45° FOV · retinal fundus photograph: 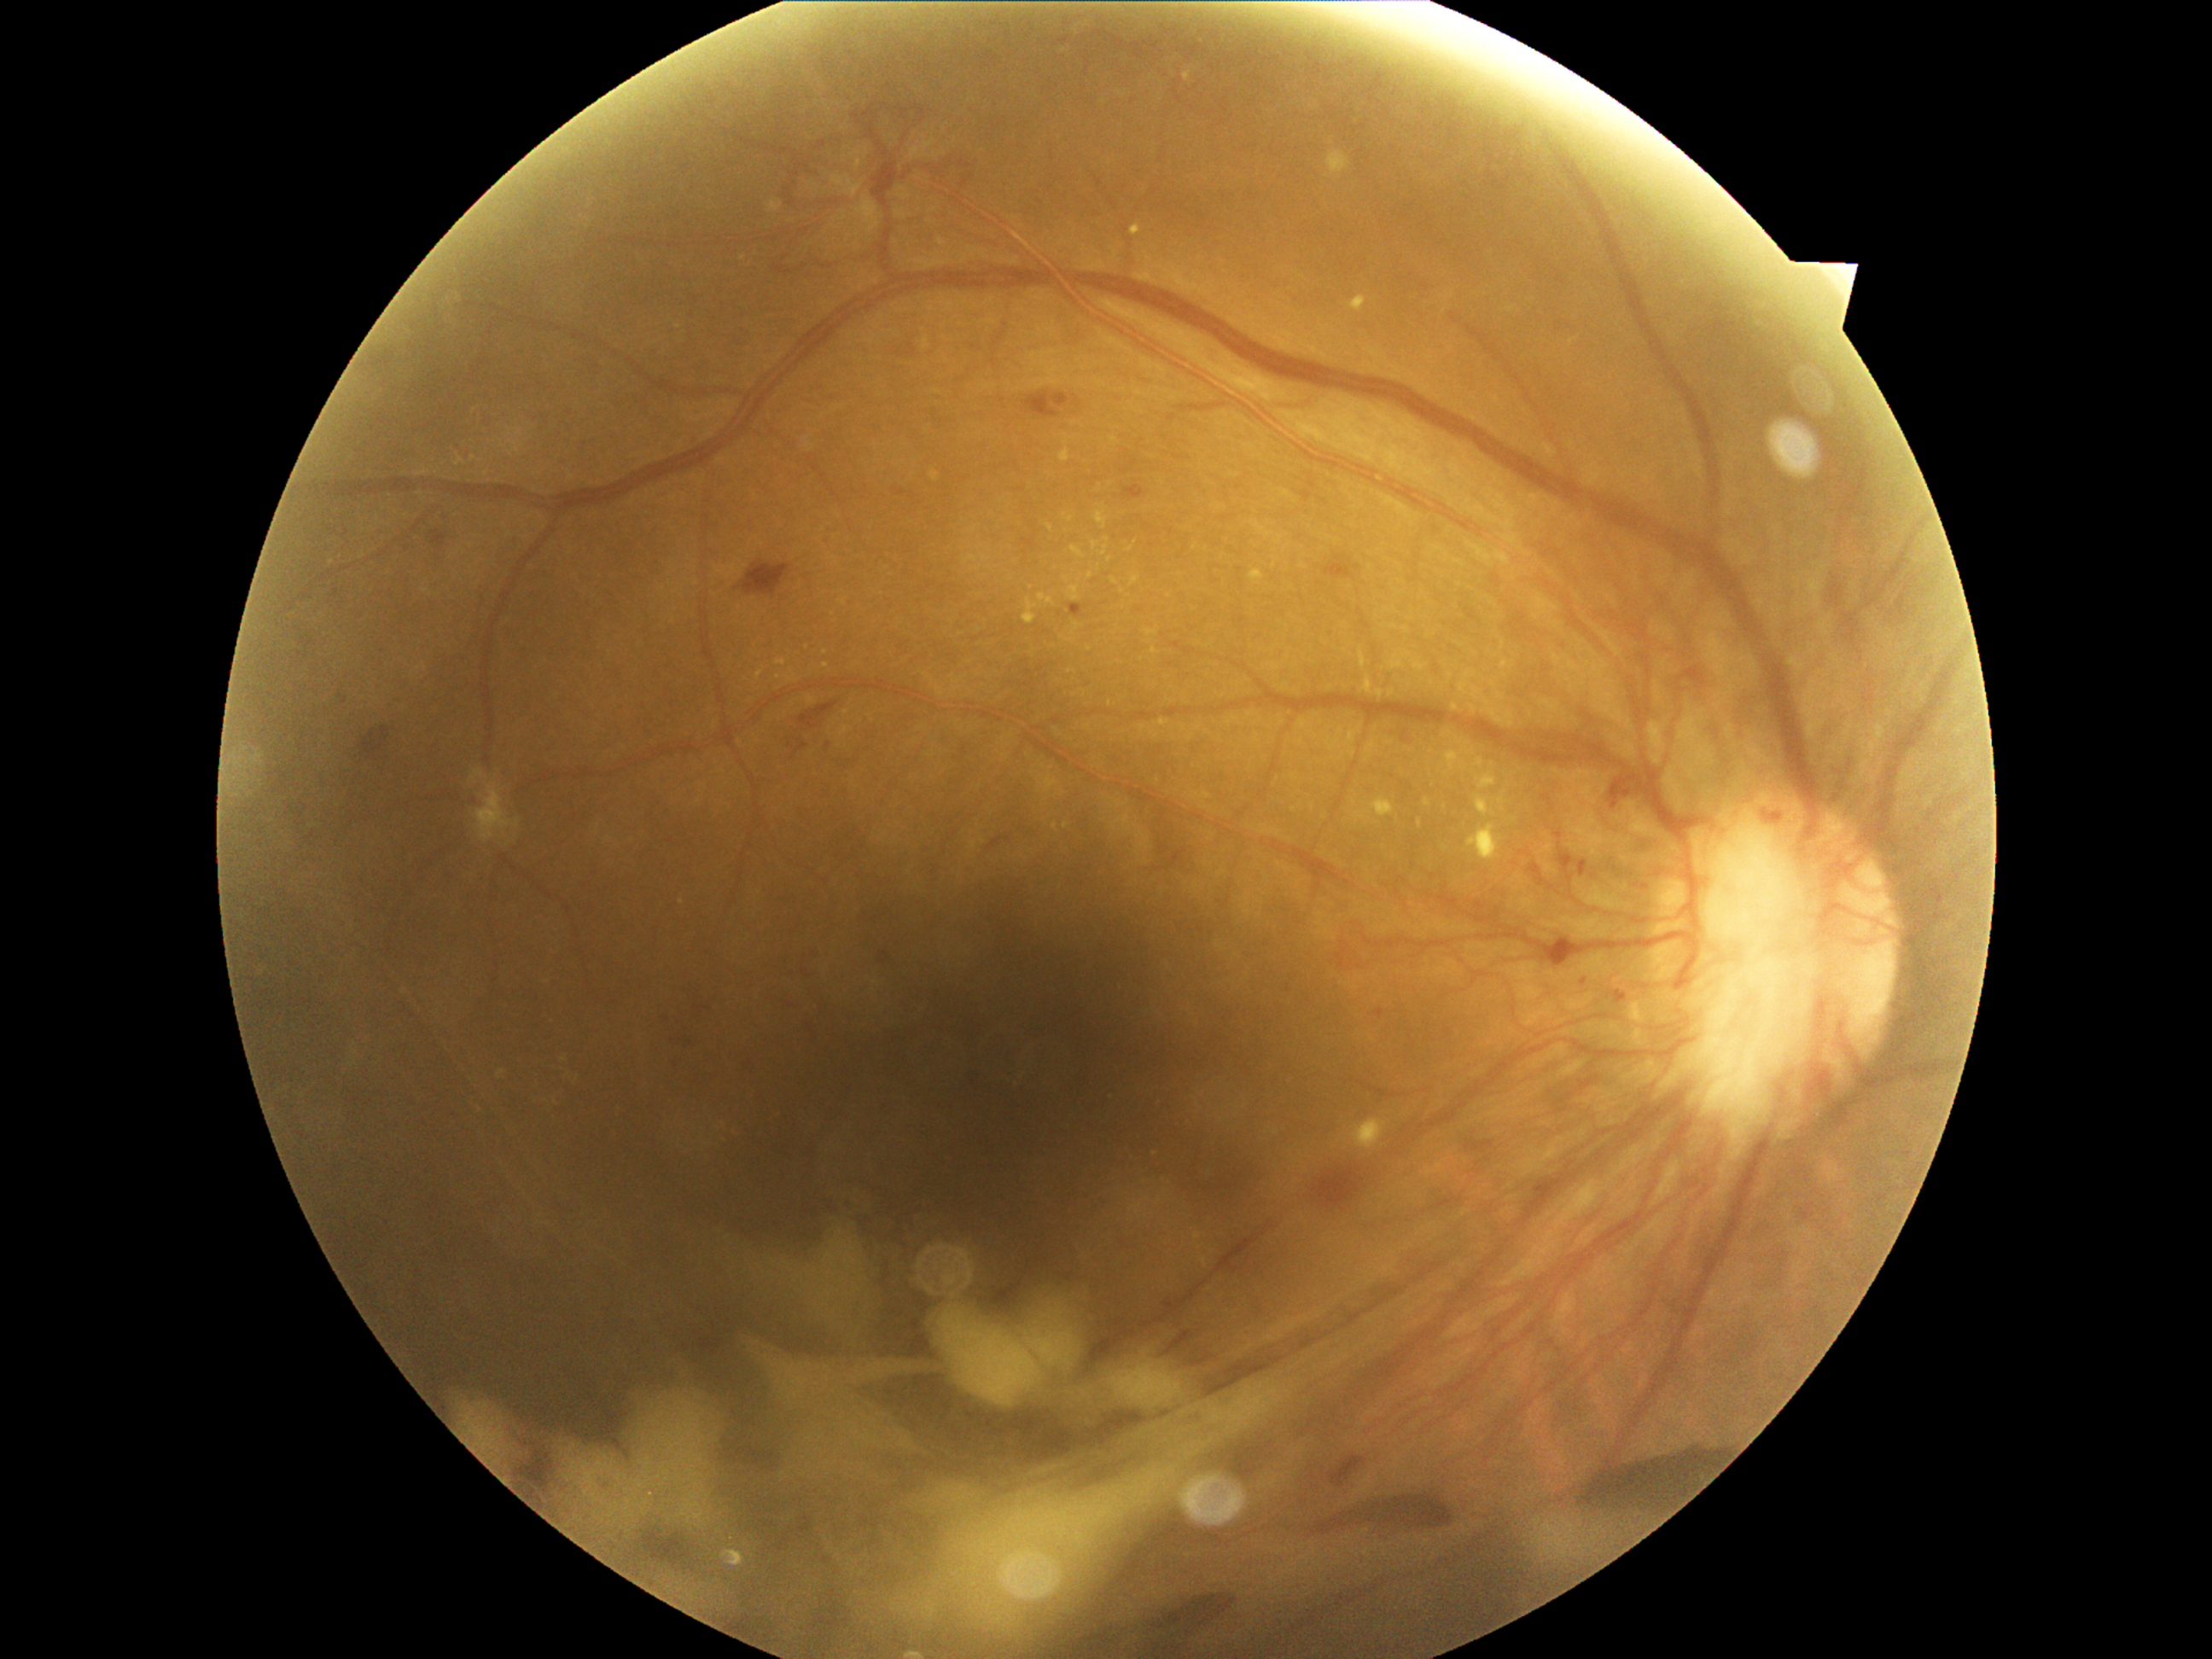

Retinopathy is grade 4 (PDR) — neovascularization and/or vitreous/pre-retinal hemorrhage.